Color fundus image; 45° field of view.
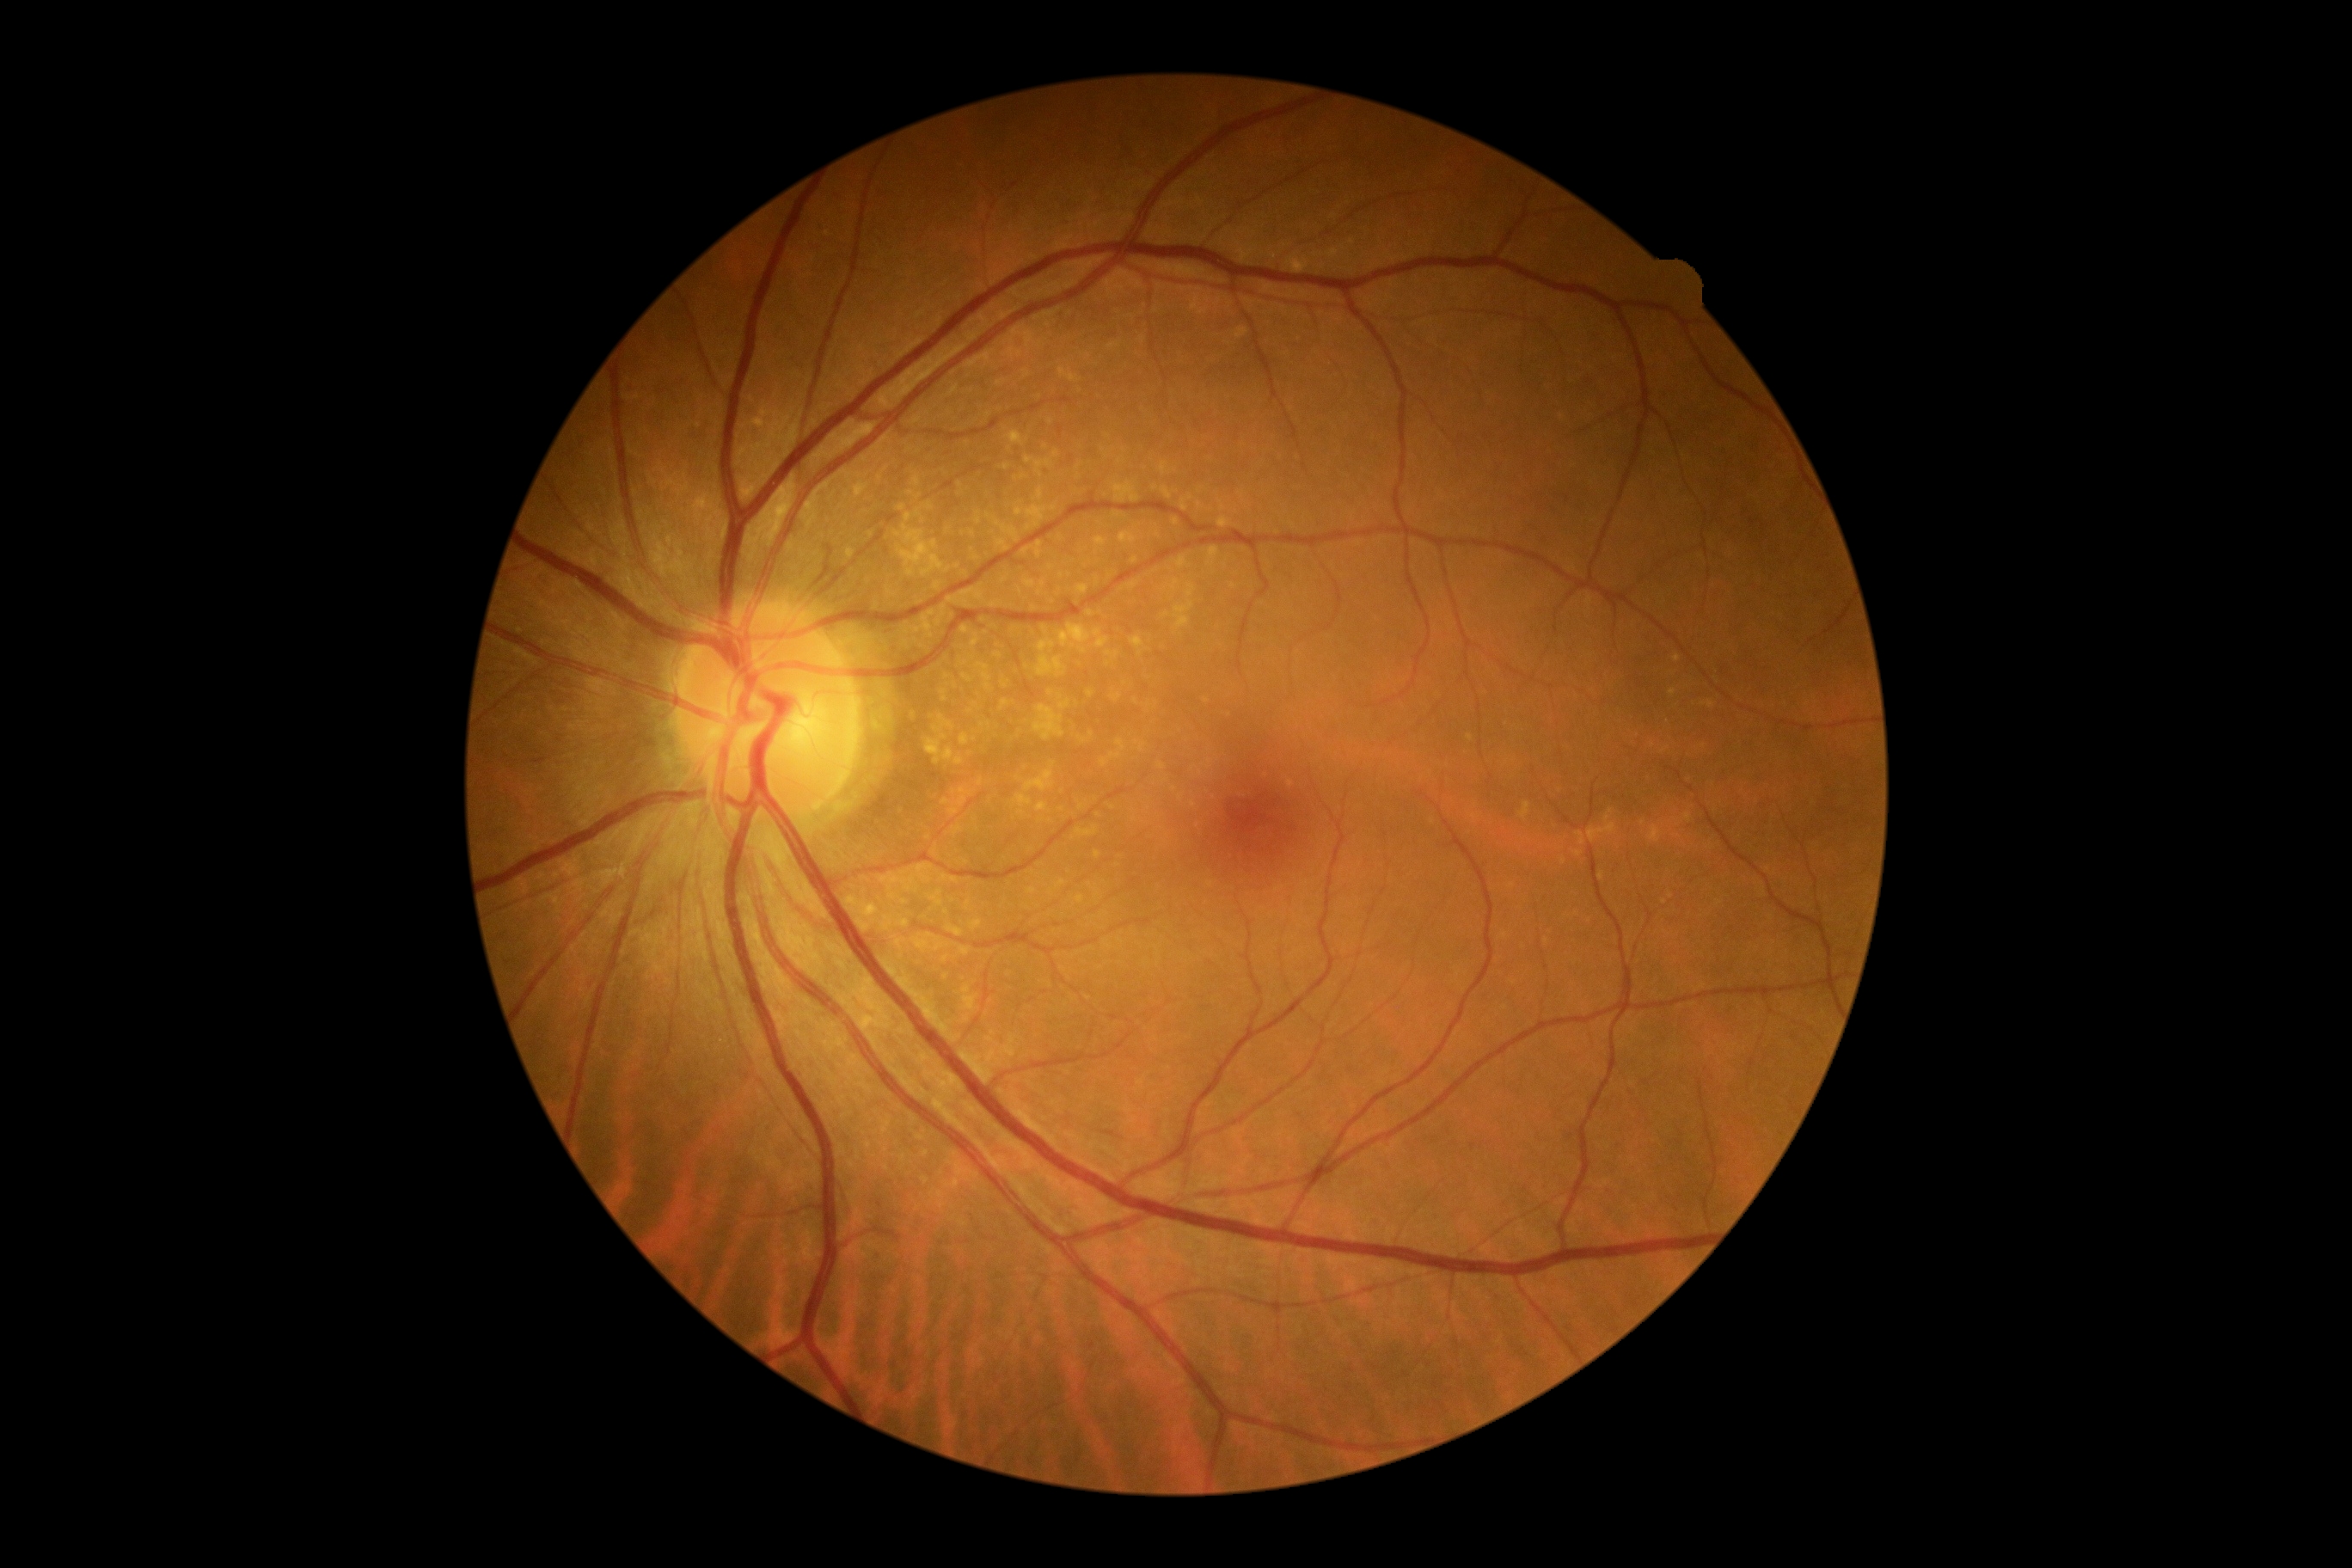 DR severity is no apparent diabetic retinopathy (grade 0).